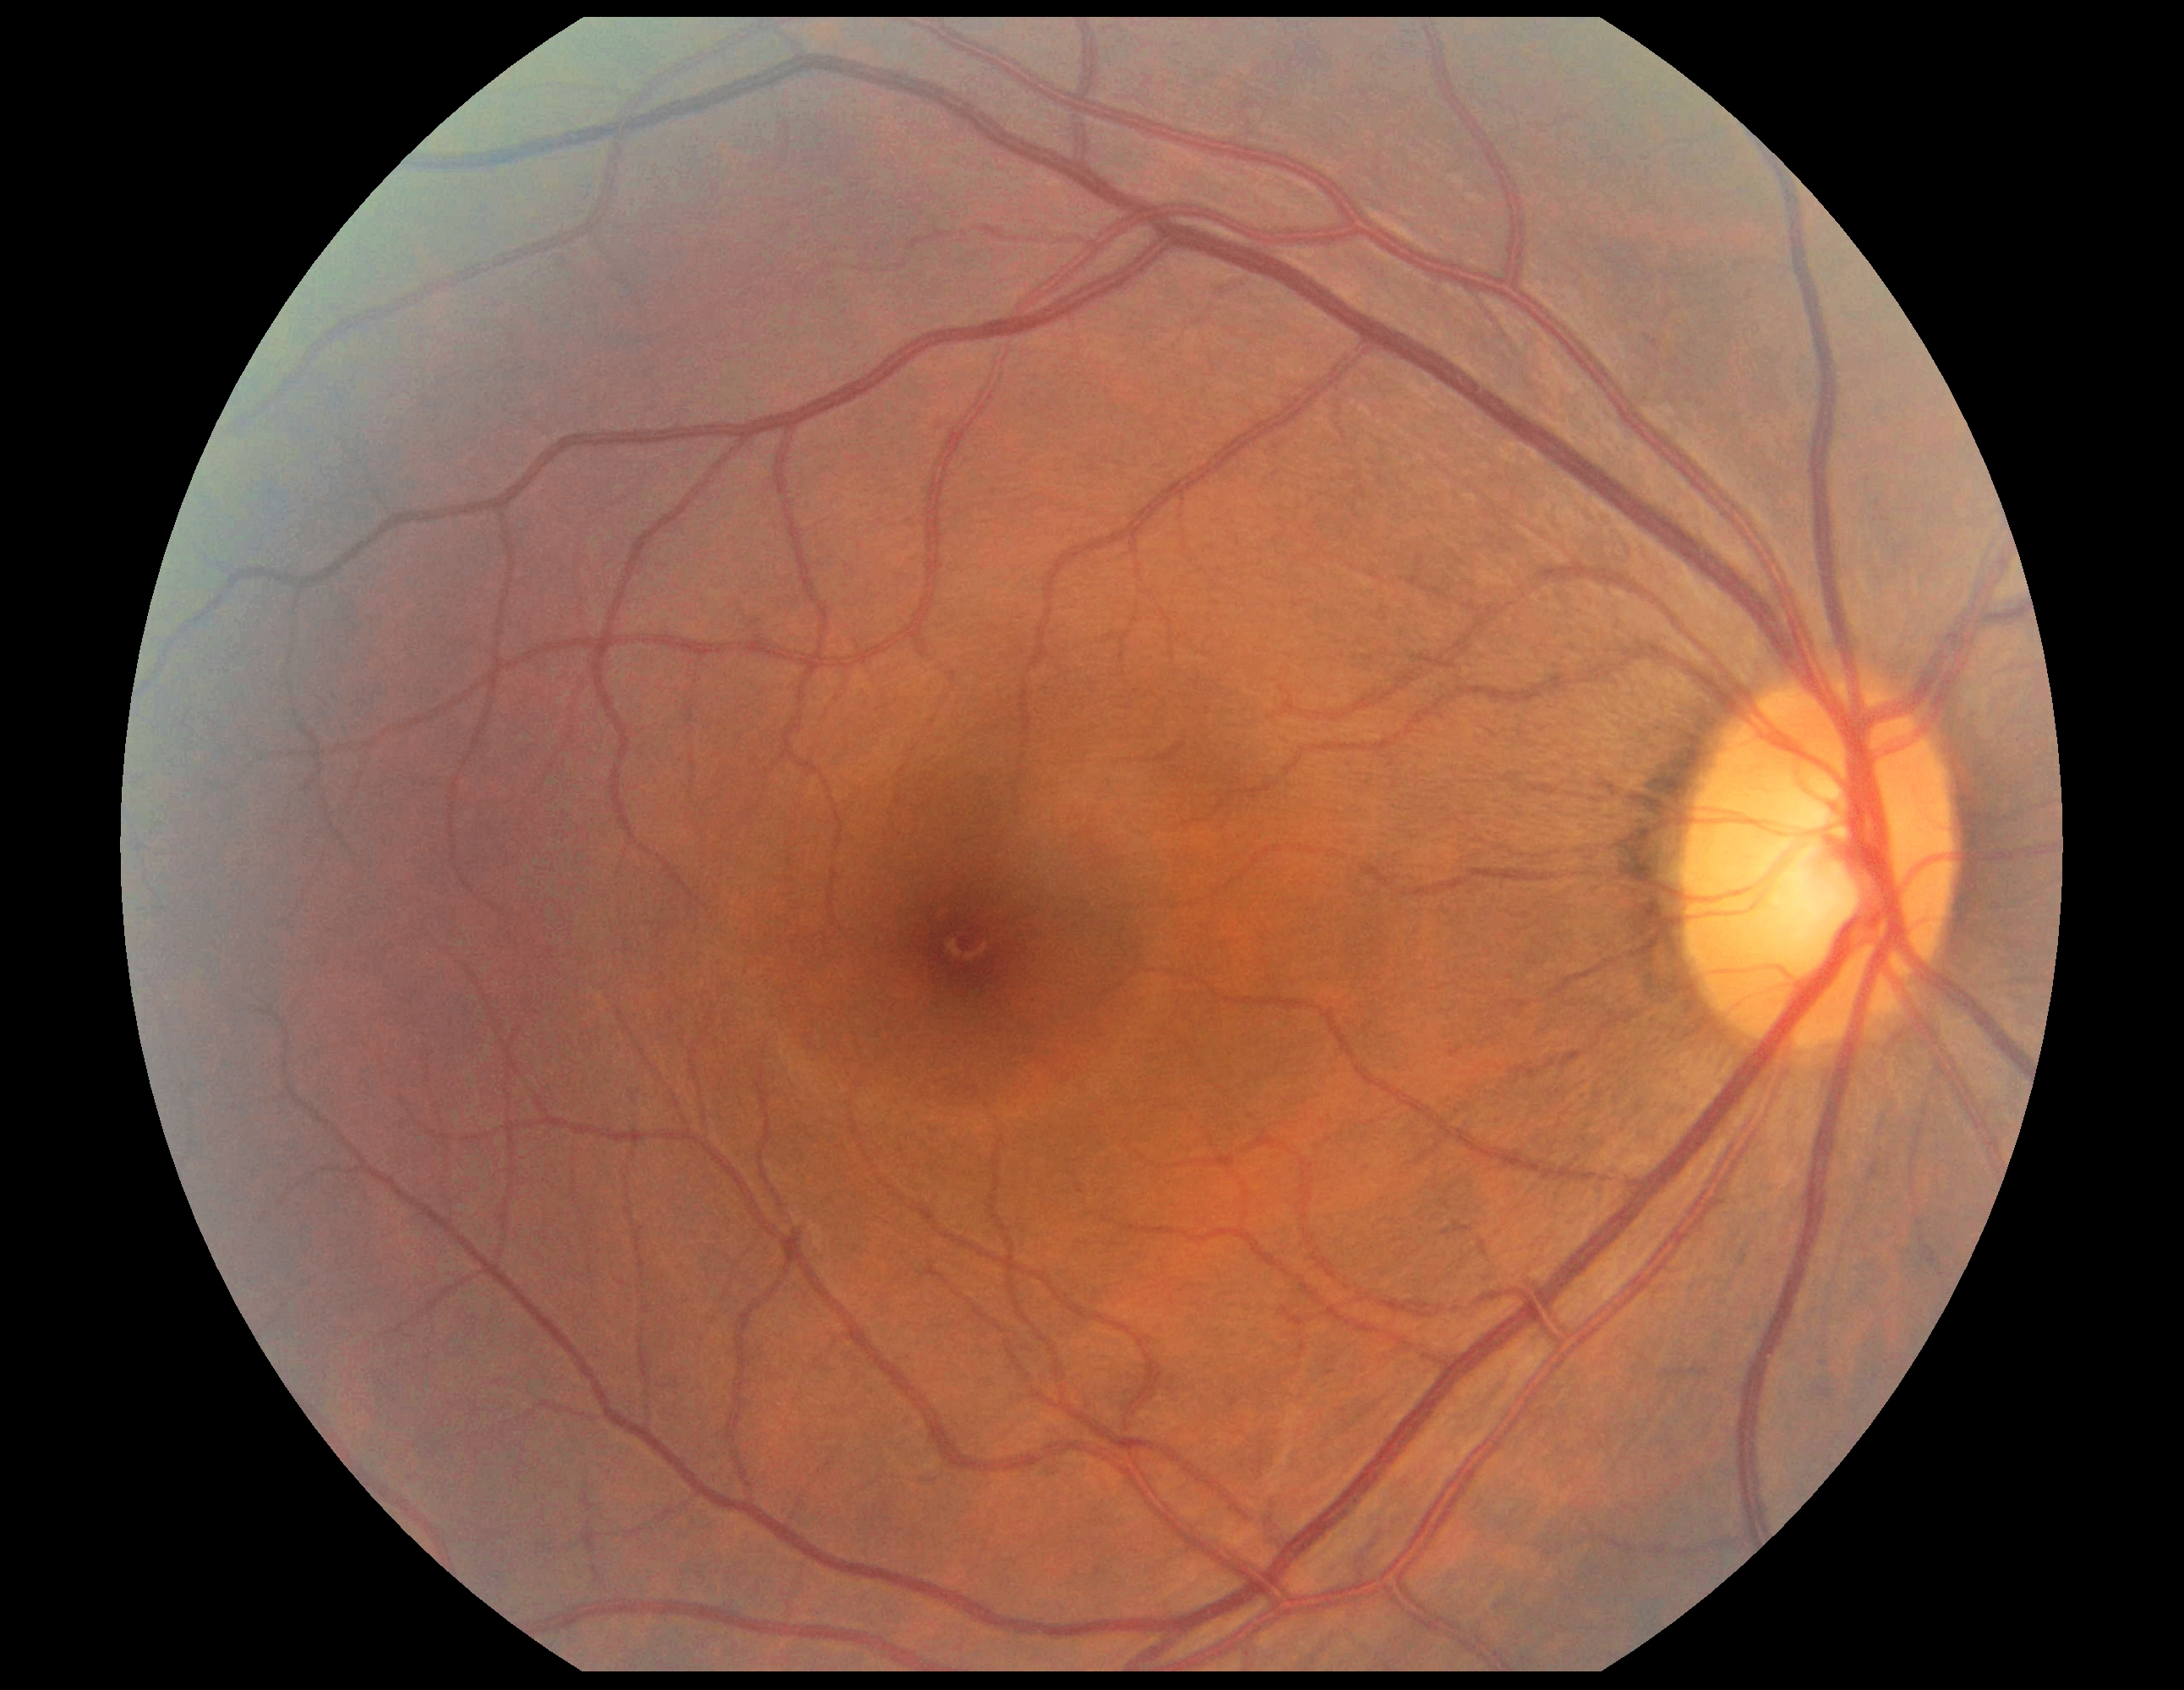 DR severity is 0/4 — no visible signs of diabetic retinopathy.